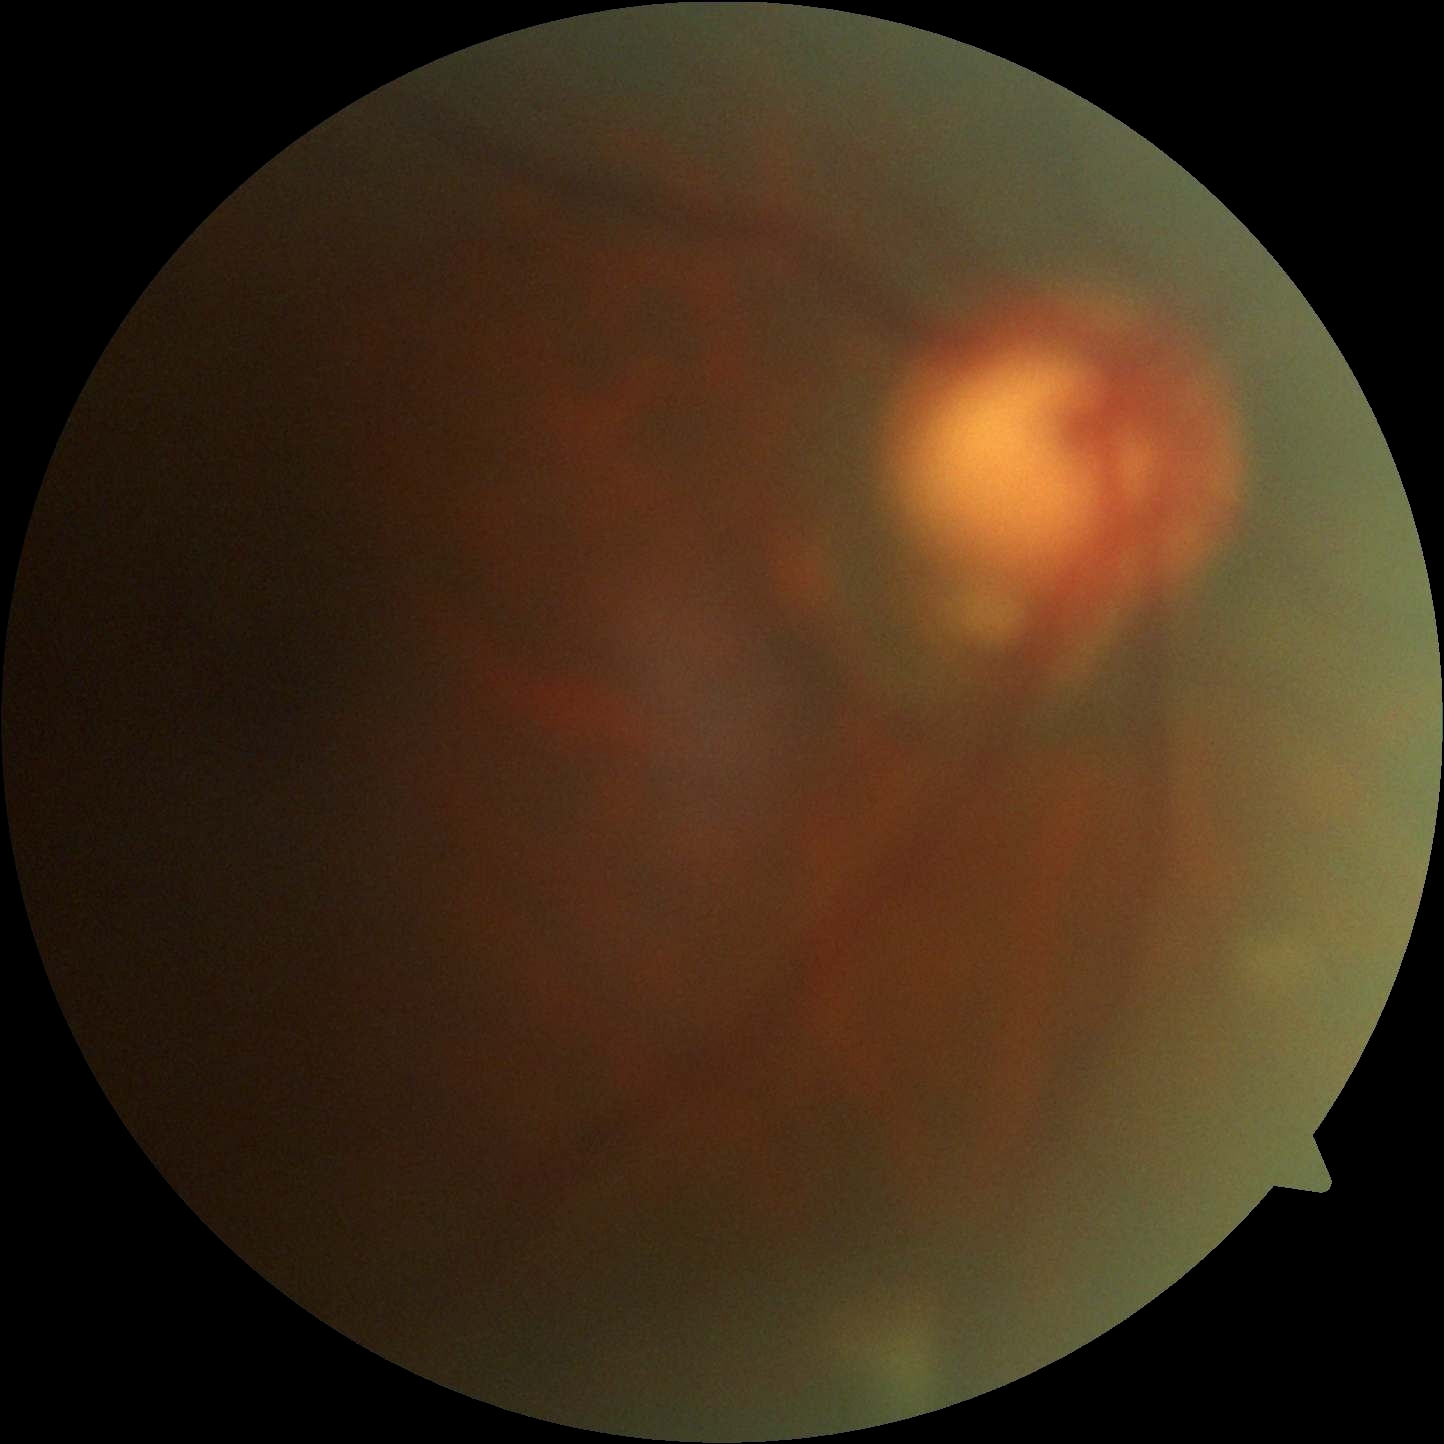
Diabetic retinopathy severity is ungradable.
Quality too poor to assess for DR.